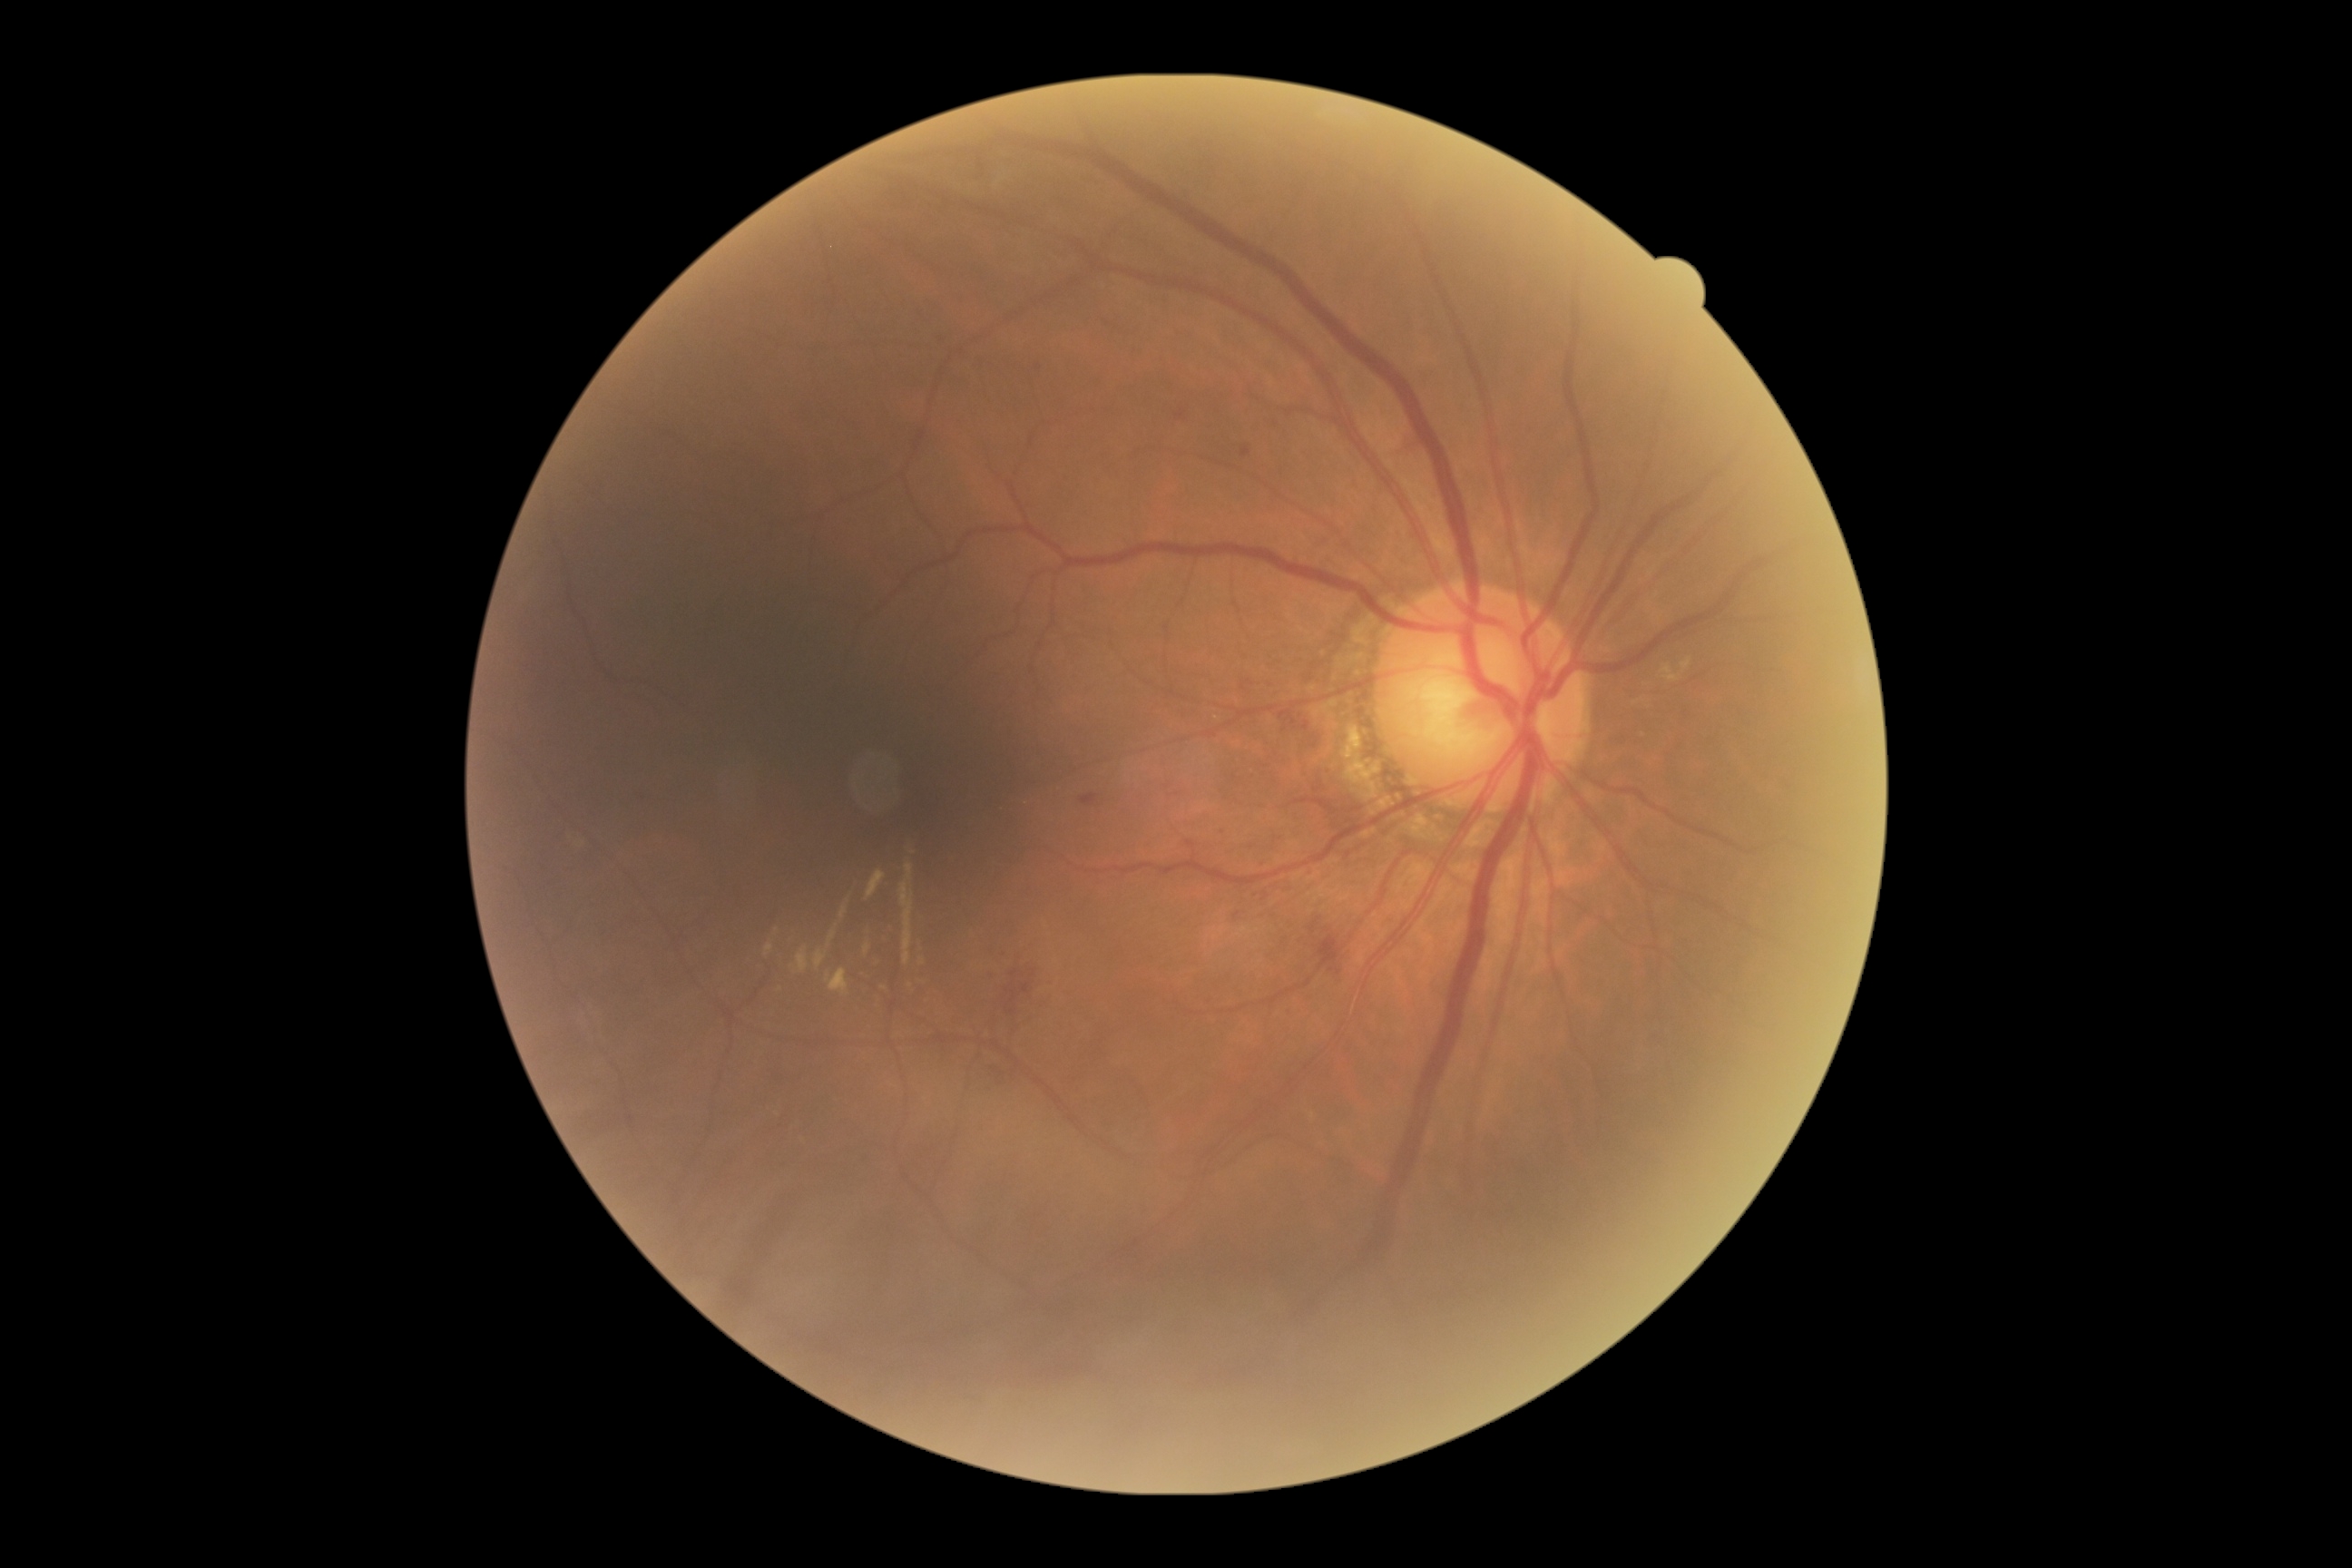

dr_grade: moderate non-proliferative diabetic retinopathy (grade 2)